Retinal fundus photograph. 2352x1568. 45° FOV — 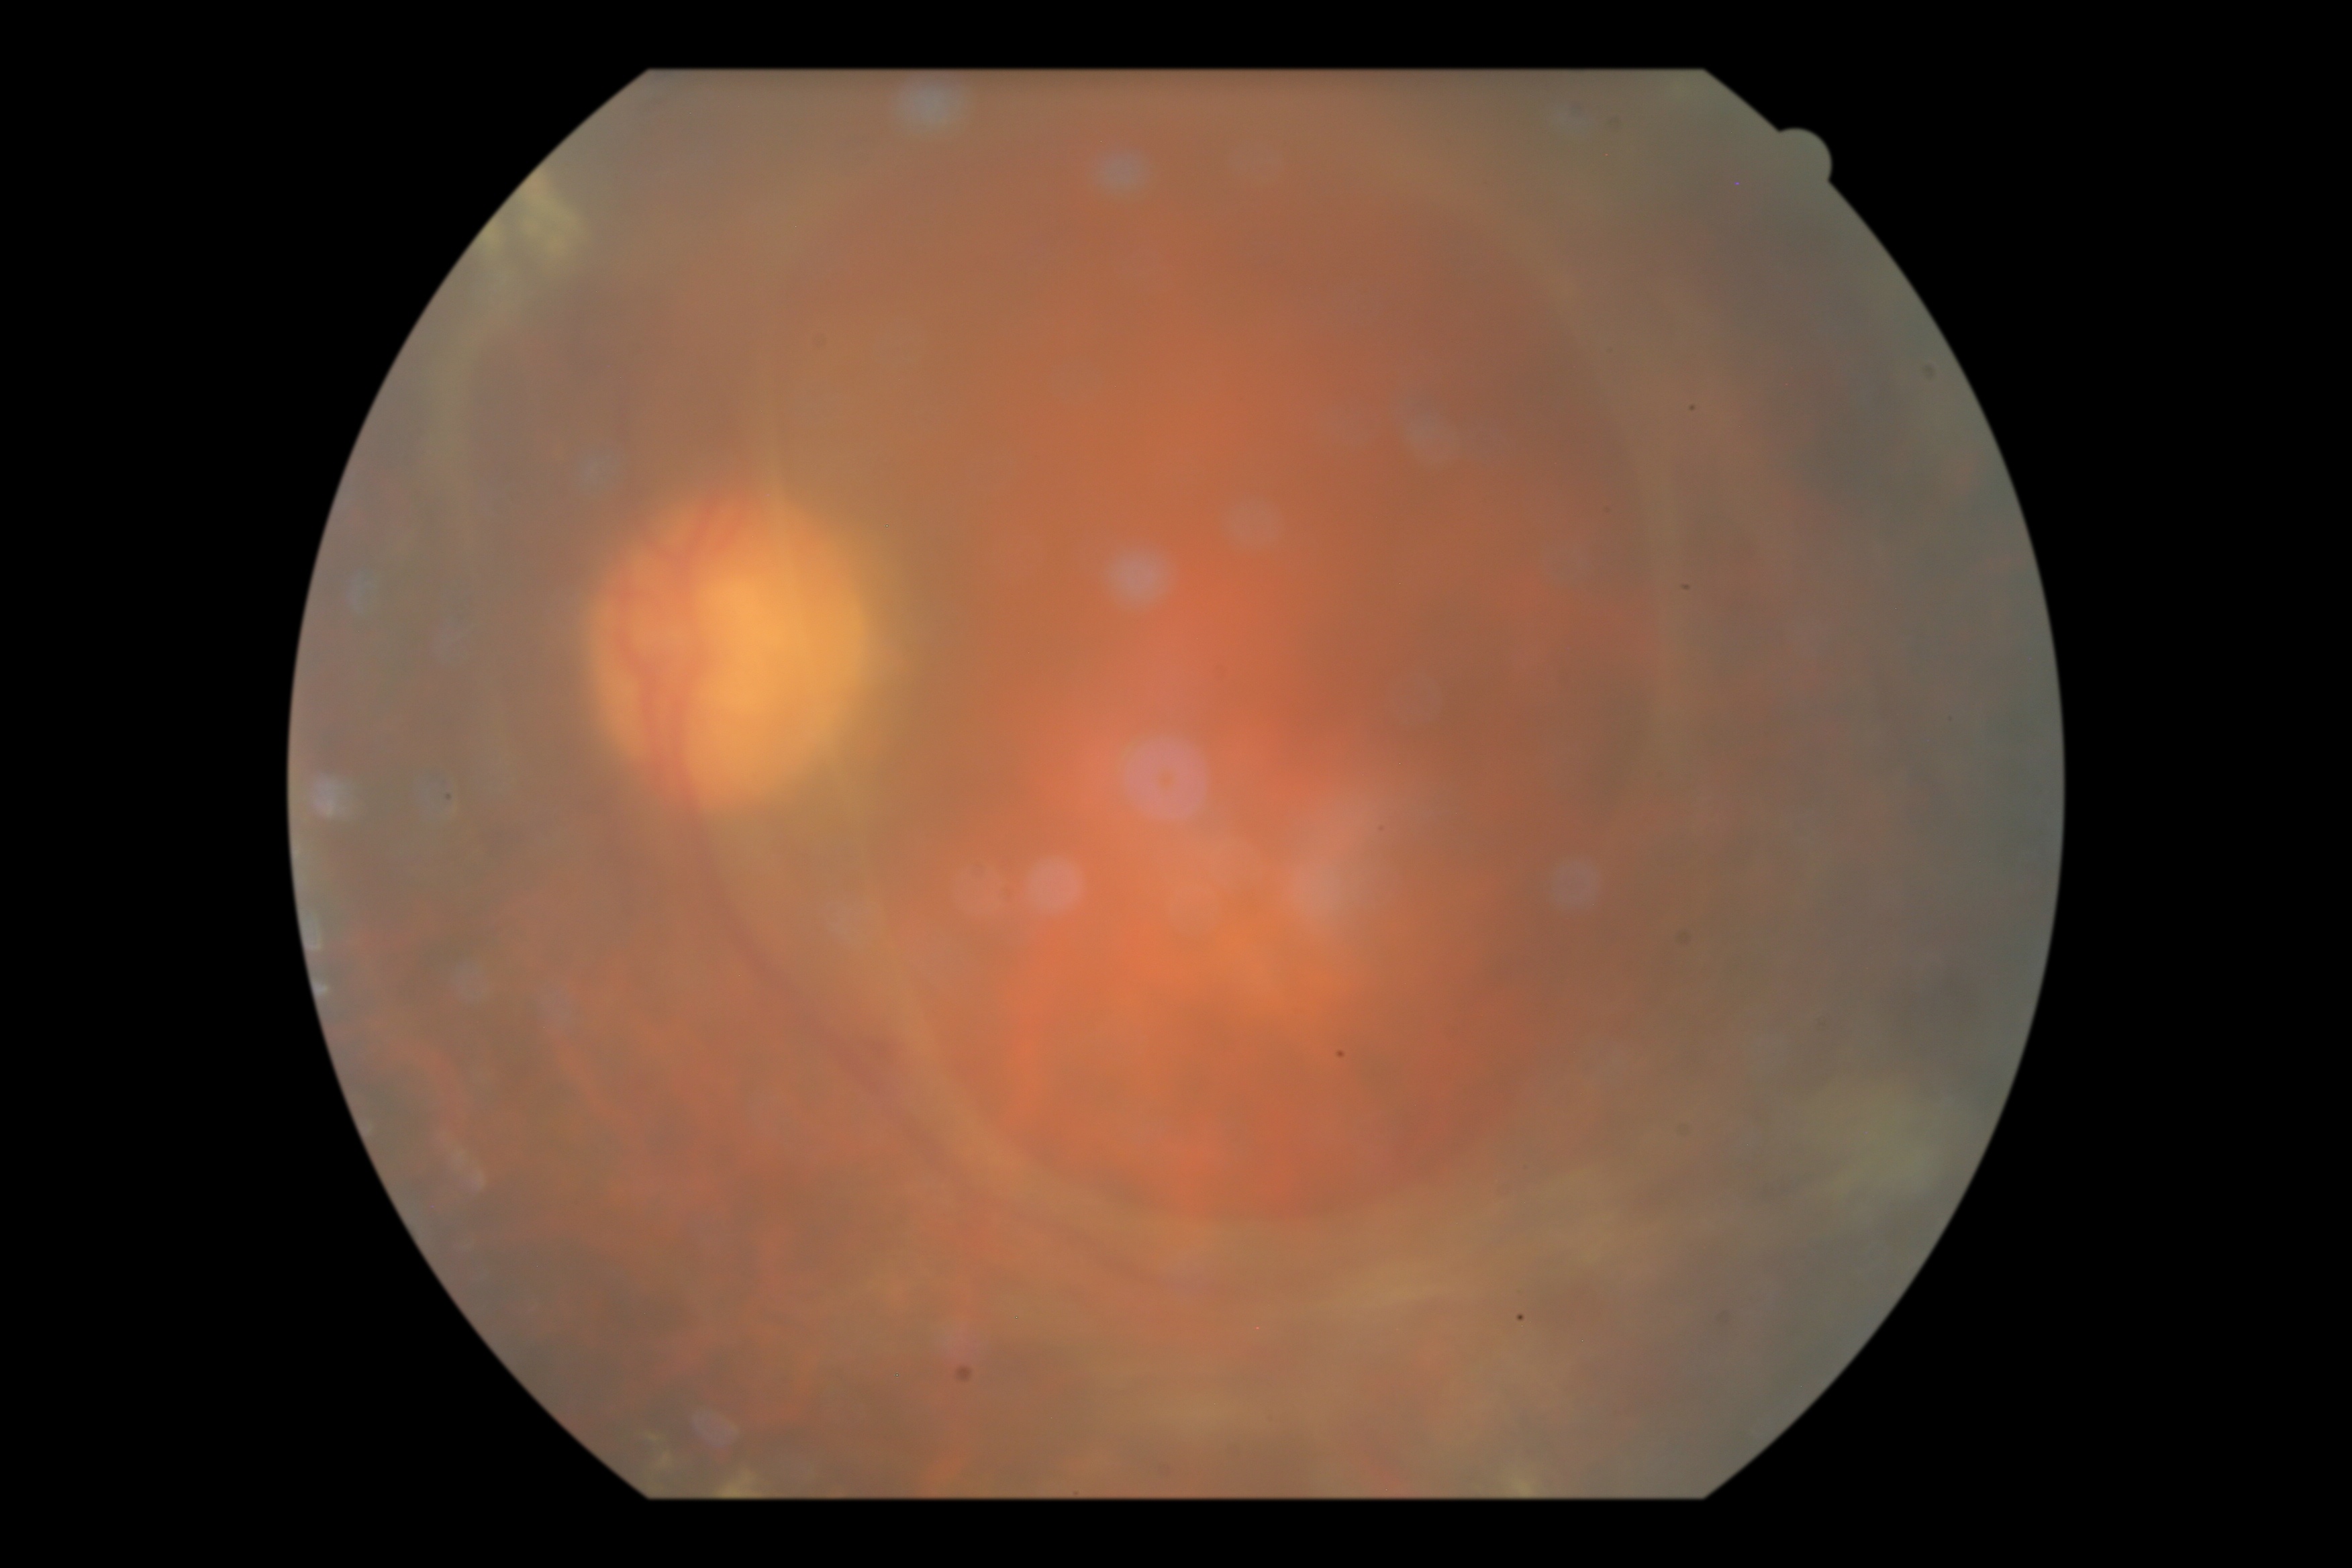 diabetic retinopathy (DR): proliferative diabetic retinopathy (grade 4); DR class: proliferative diabetic retinopathy.